1659x2212px: 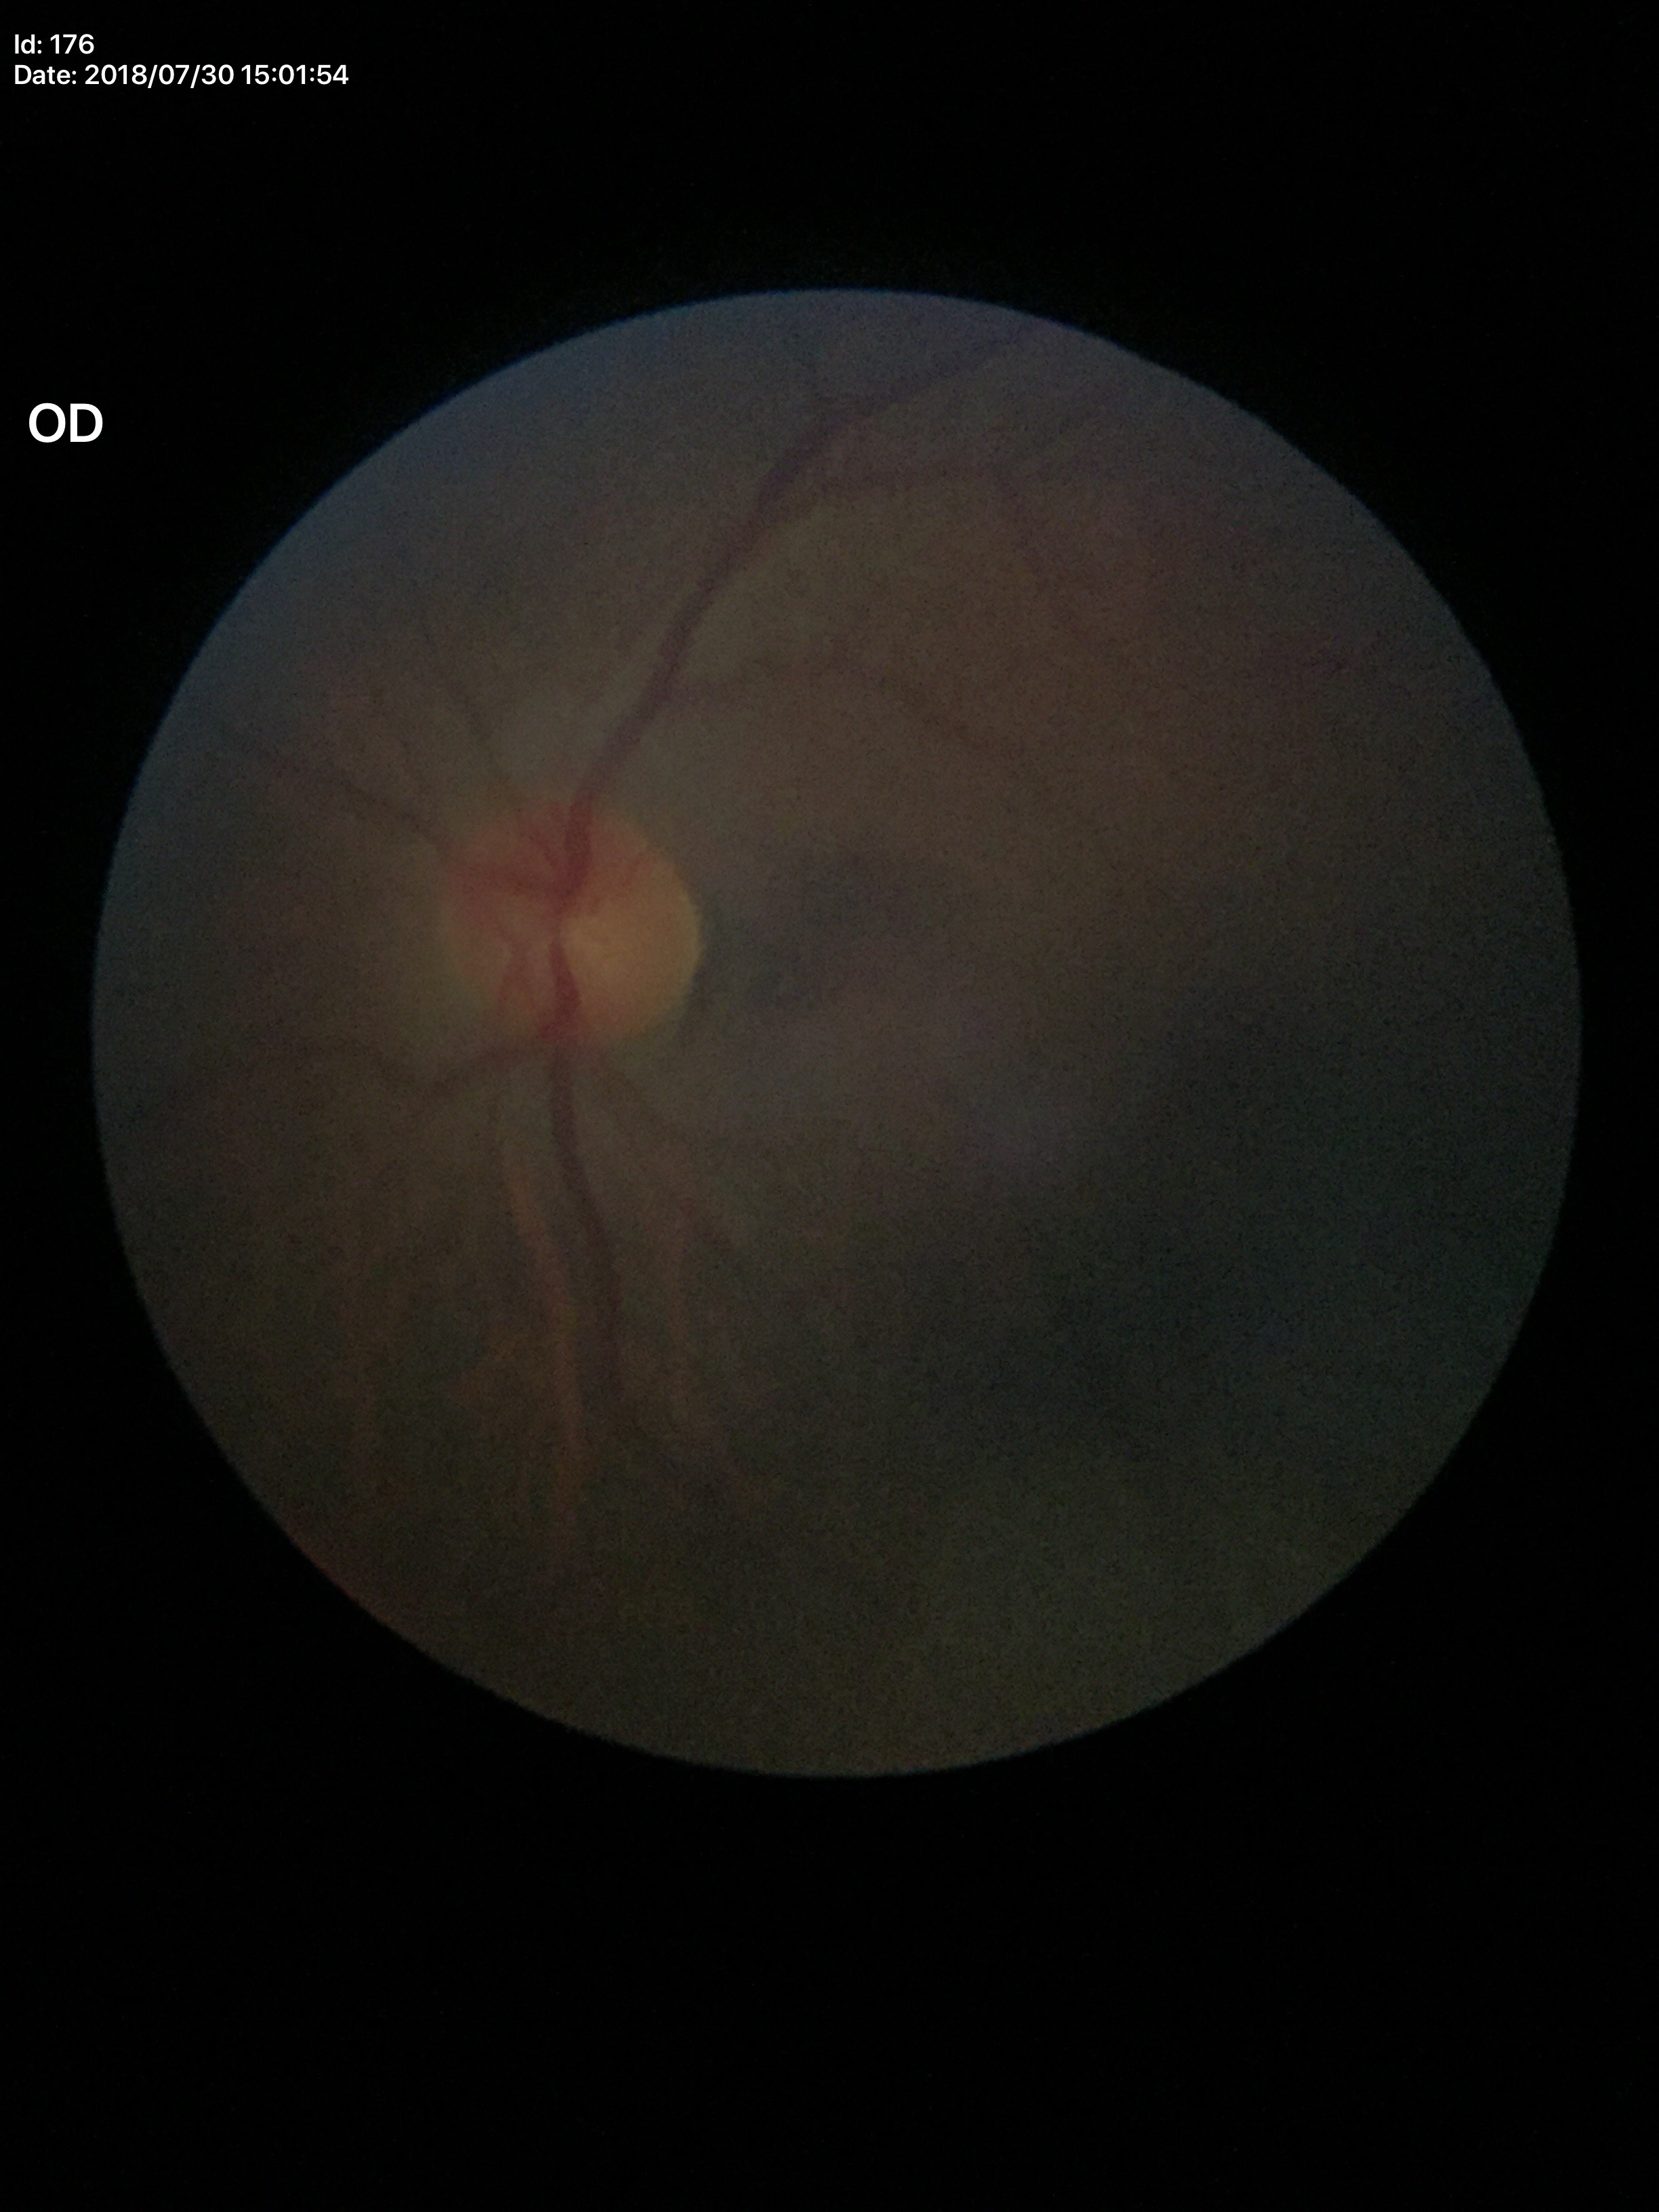

Horizontal cup-to-disc ratio (HCDR) of 0.43.
Vertical cup-disc ratio (VCDR) is 0.45.
No signs of glaucoma (unanimous normal call).